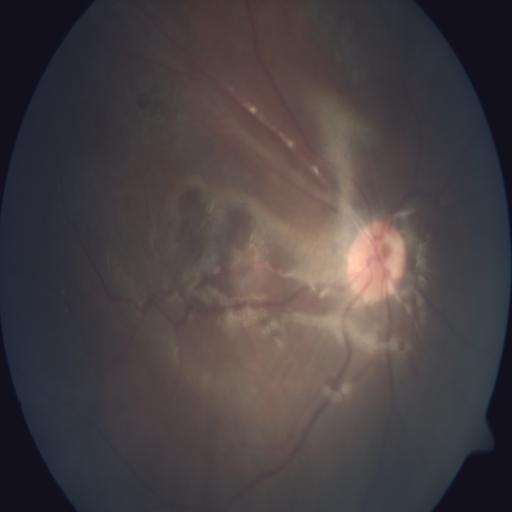

Abnormalities: retinal traction.